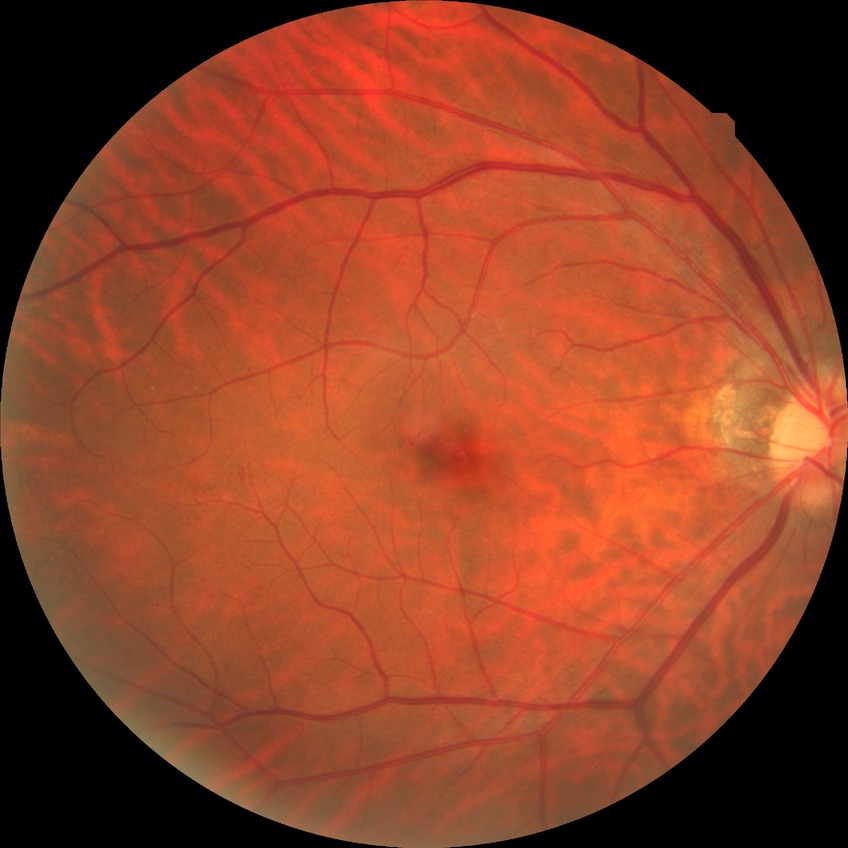

diabetic retinopathy (DR) = NDR (no diabetic retinopathy).